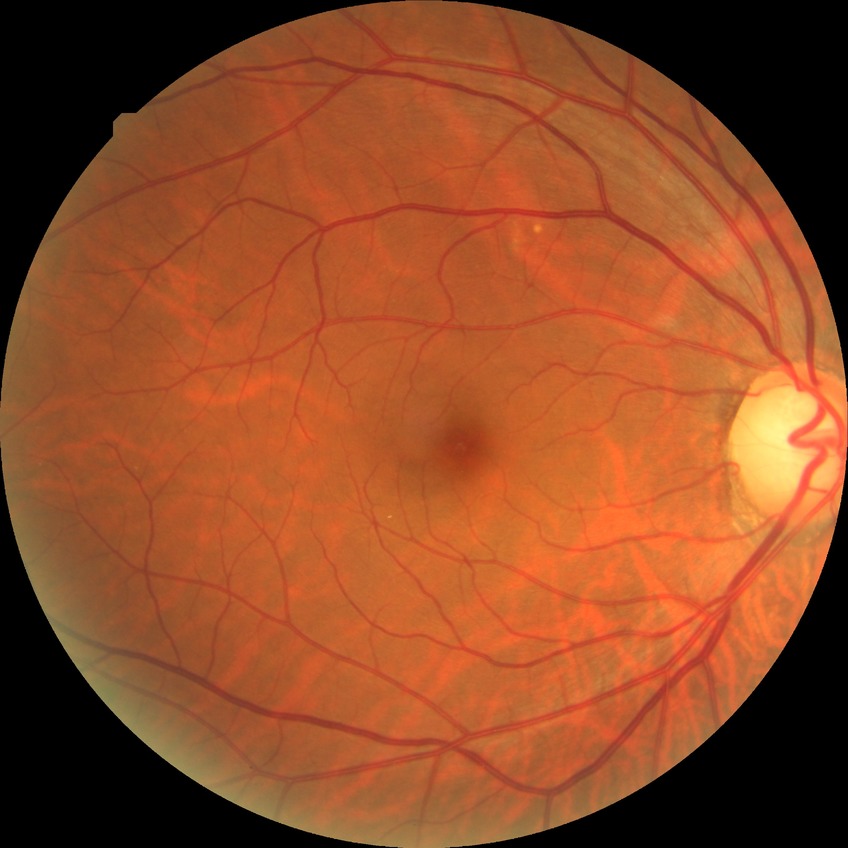

diabetic retinopathy (DR): NDR (no diabetic retinopathy)